45-degree field of view
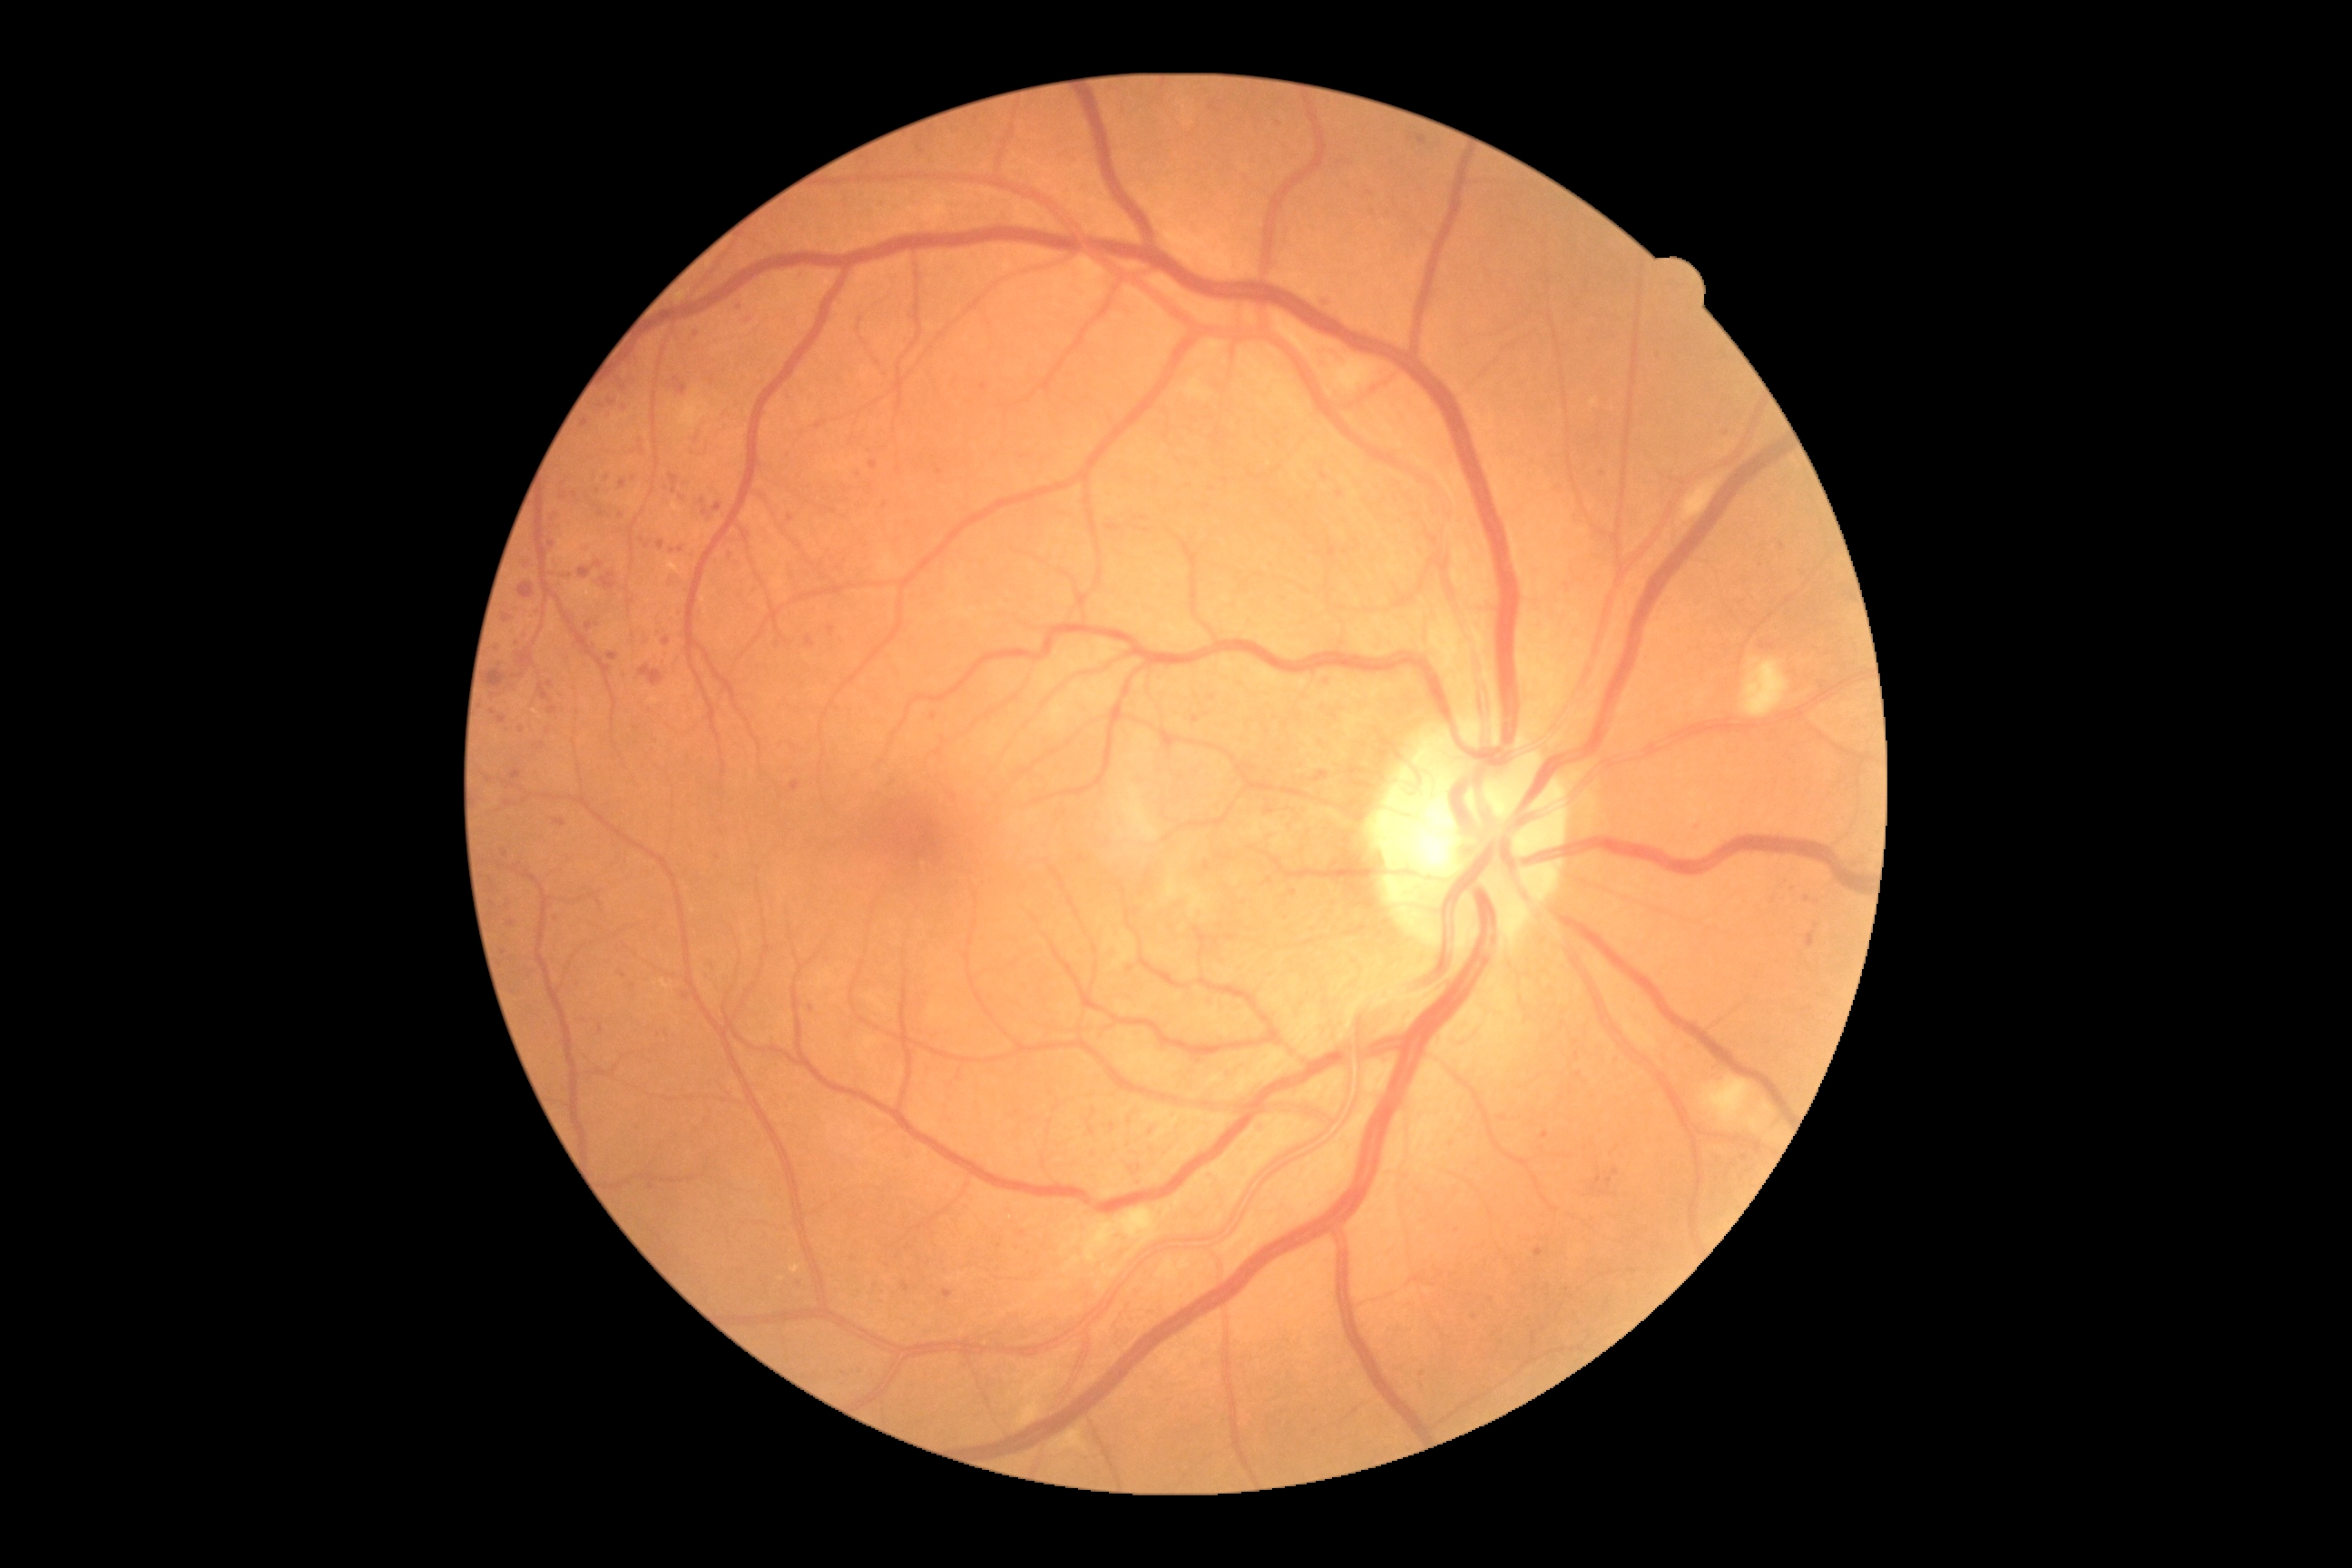
<lesions partial="true">
  <dr_grade>2</dr_grade>
  <se>1701 1075 1754 1124 | 1741 658 1790 718 | 1050 1427 1086 1453 | 1084 1208 1159 1264 | 1184 380 1213 402 | 1164 876 1181 899 | 1186 888 1208 917 | 1315 357 1380 393 | 1015 1369 1059 1429 | 1681 478 1721 524</se>
  <he>671 473 680 495 | 1313 770 1329 778 | 511 770 522 781 | 593 562 603 567 | 600 573 616 591 | 516 649 534 667 | 1318 299 1335 309 | 487 671 507 687 | 1318 680 1333 687 | 805 636 814 647 | 580 567 593 580 | 554 818 565 827 | 640 665 665 687 | 518 583 534 600 | 1318 734 1329 745 | 1807 932 1816 948 | 1416 135 1427 148</he>
  <ex partial="true">667 562 680 574 | 790 1264 801 1273 | 514 696 525 707</ex>
  <ex_small_approx>(782, 1278)</ex_small_approx>
  <ma partial="true">502 848 509 858 | 868 460 879 471 | 1110 1124 1115 1132 | 547 681 554 689 | 943 1289 954 1298 | 598 1024 603 1034</ma>
  <ma_small_approx>(1454, 1140) | (527, 565) | (697, 335) | (1782, 546) | (703, 501) | (859, 474) | (660, 634) | (871, 487) | (510, 923) | (1807, 899) | (602, 407) | (1093, 1110)</ma_small_approx>
</lesions>